2212 by 1659 pixels, 45° FOV:
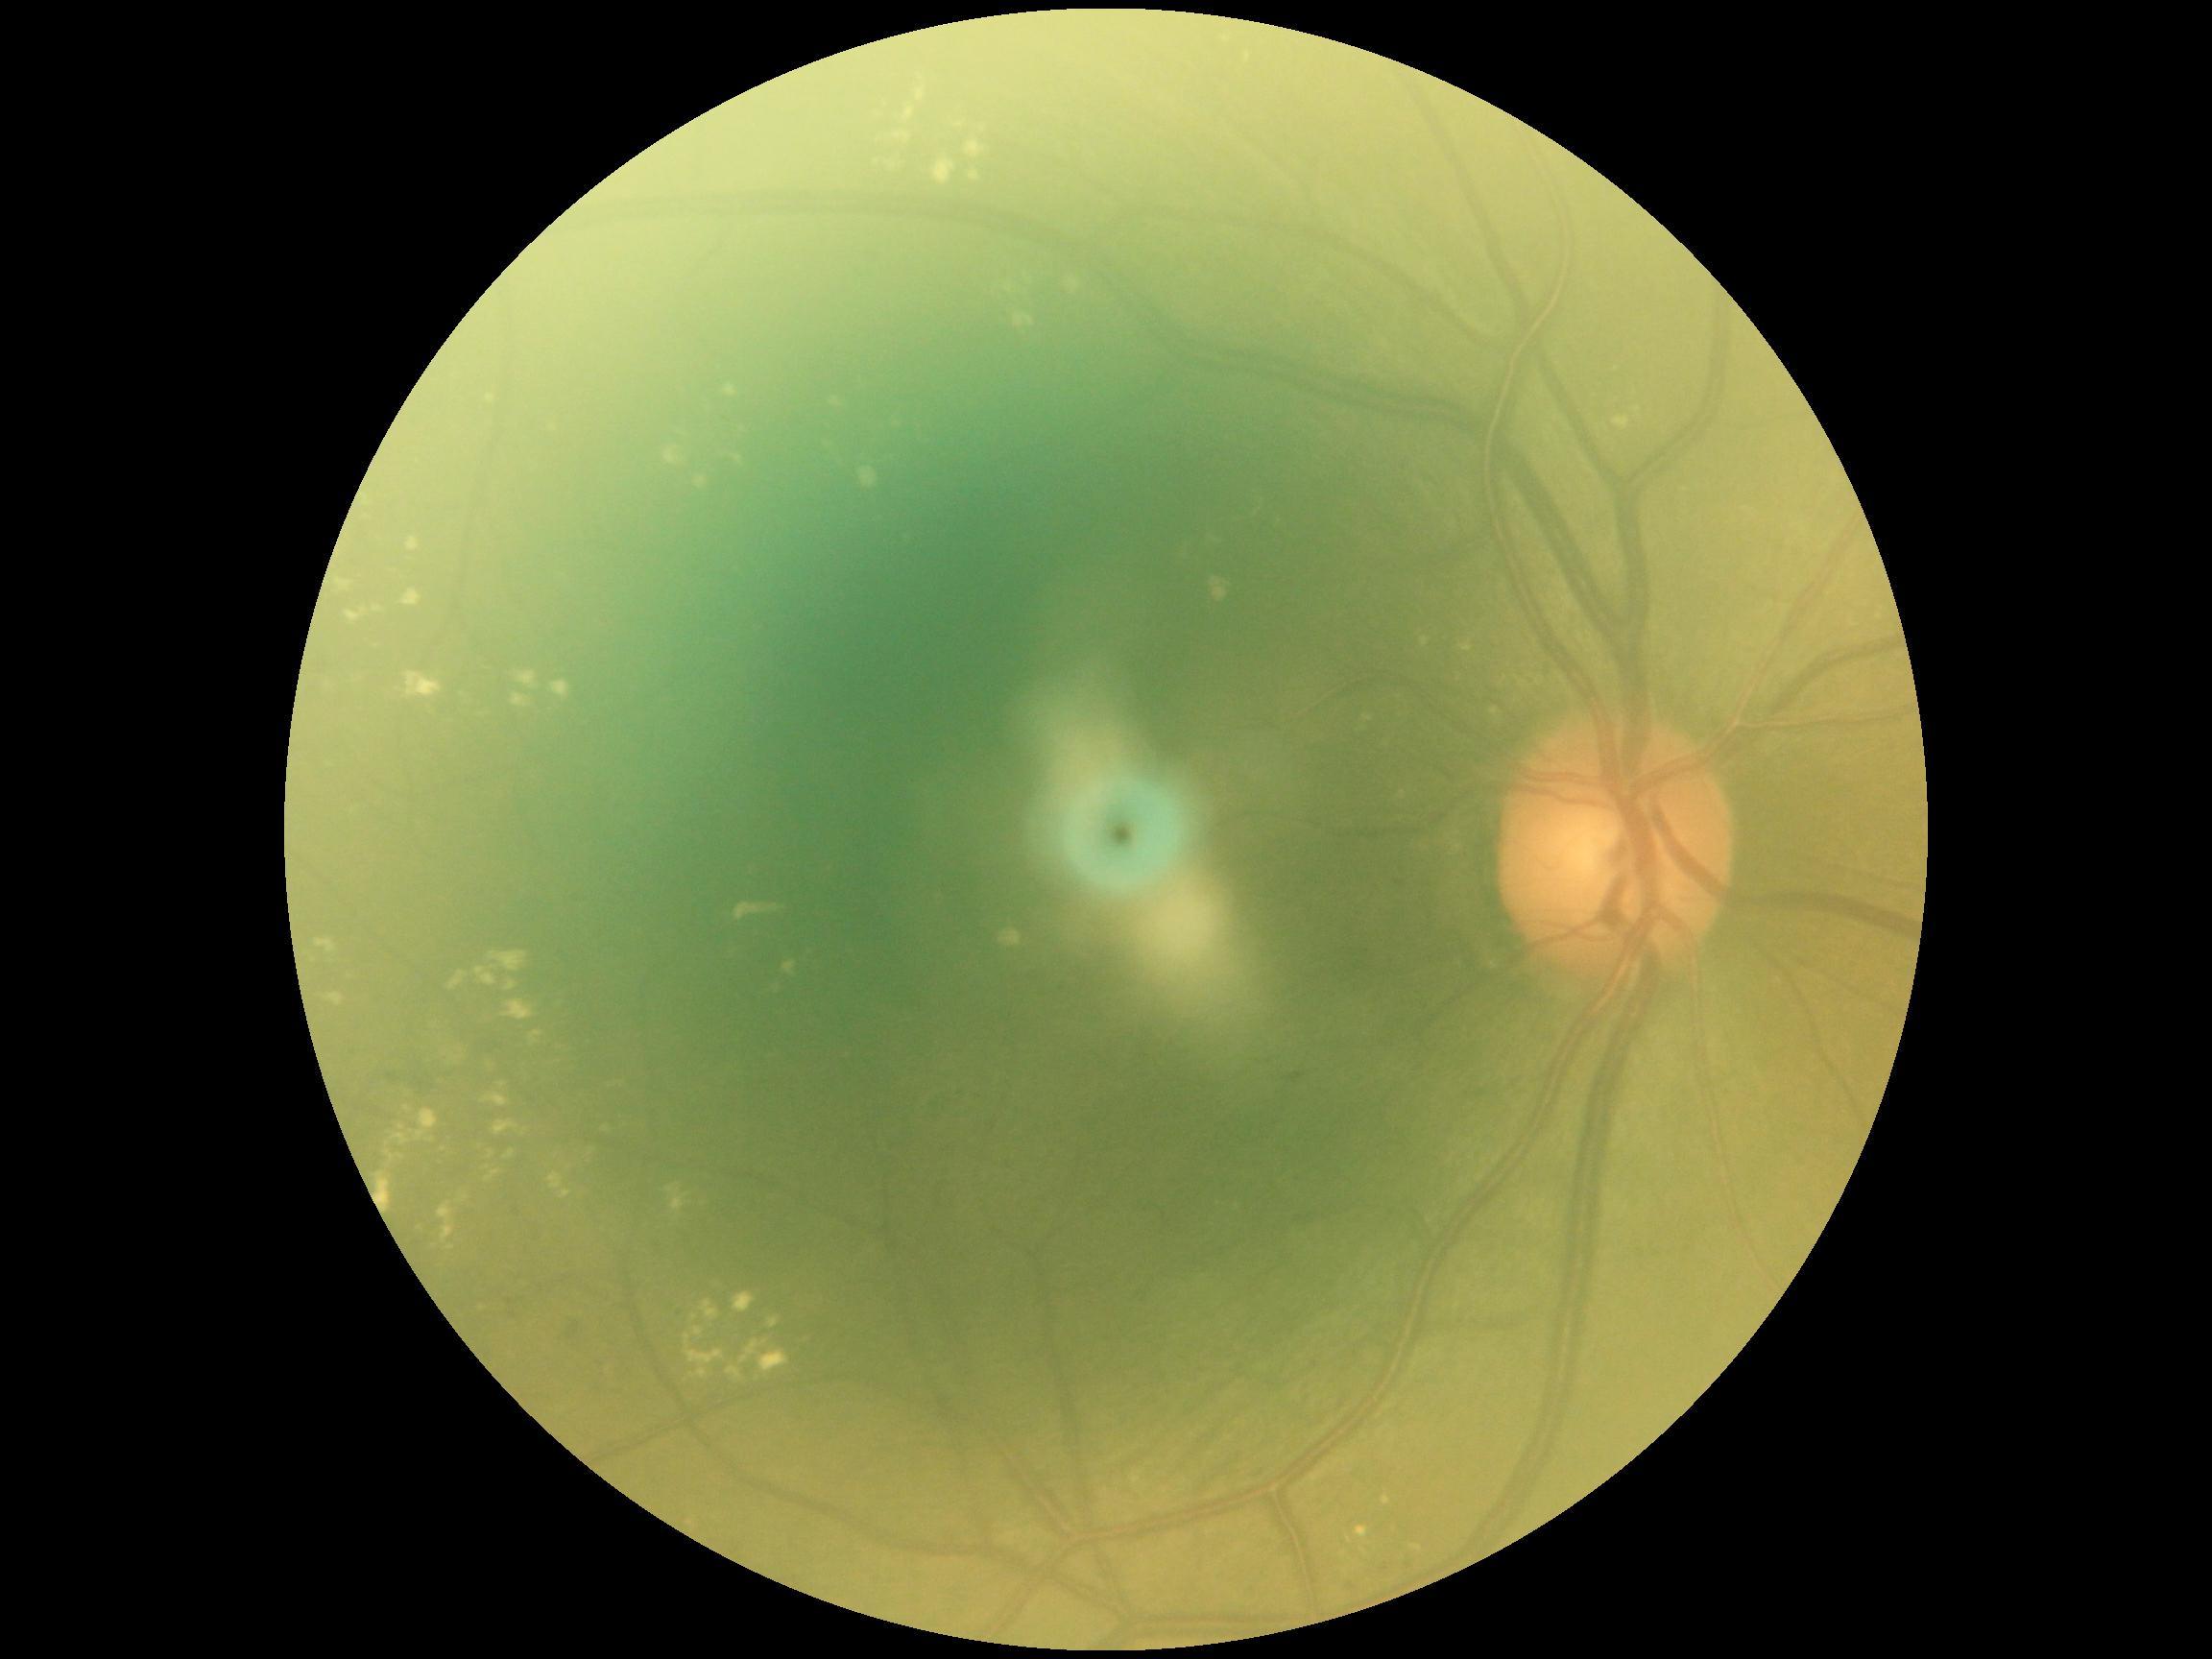 DR stage is 2.